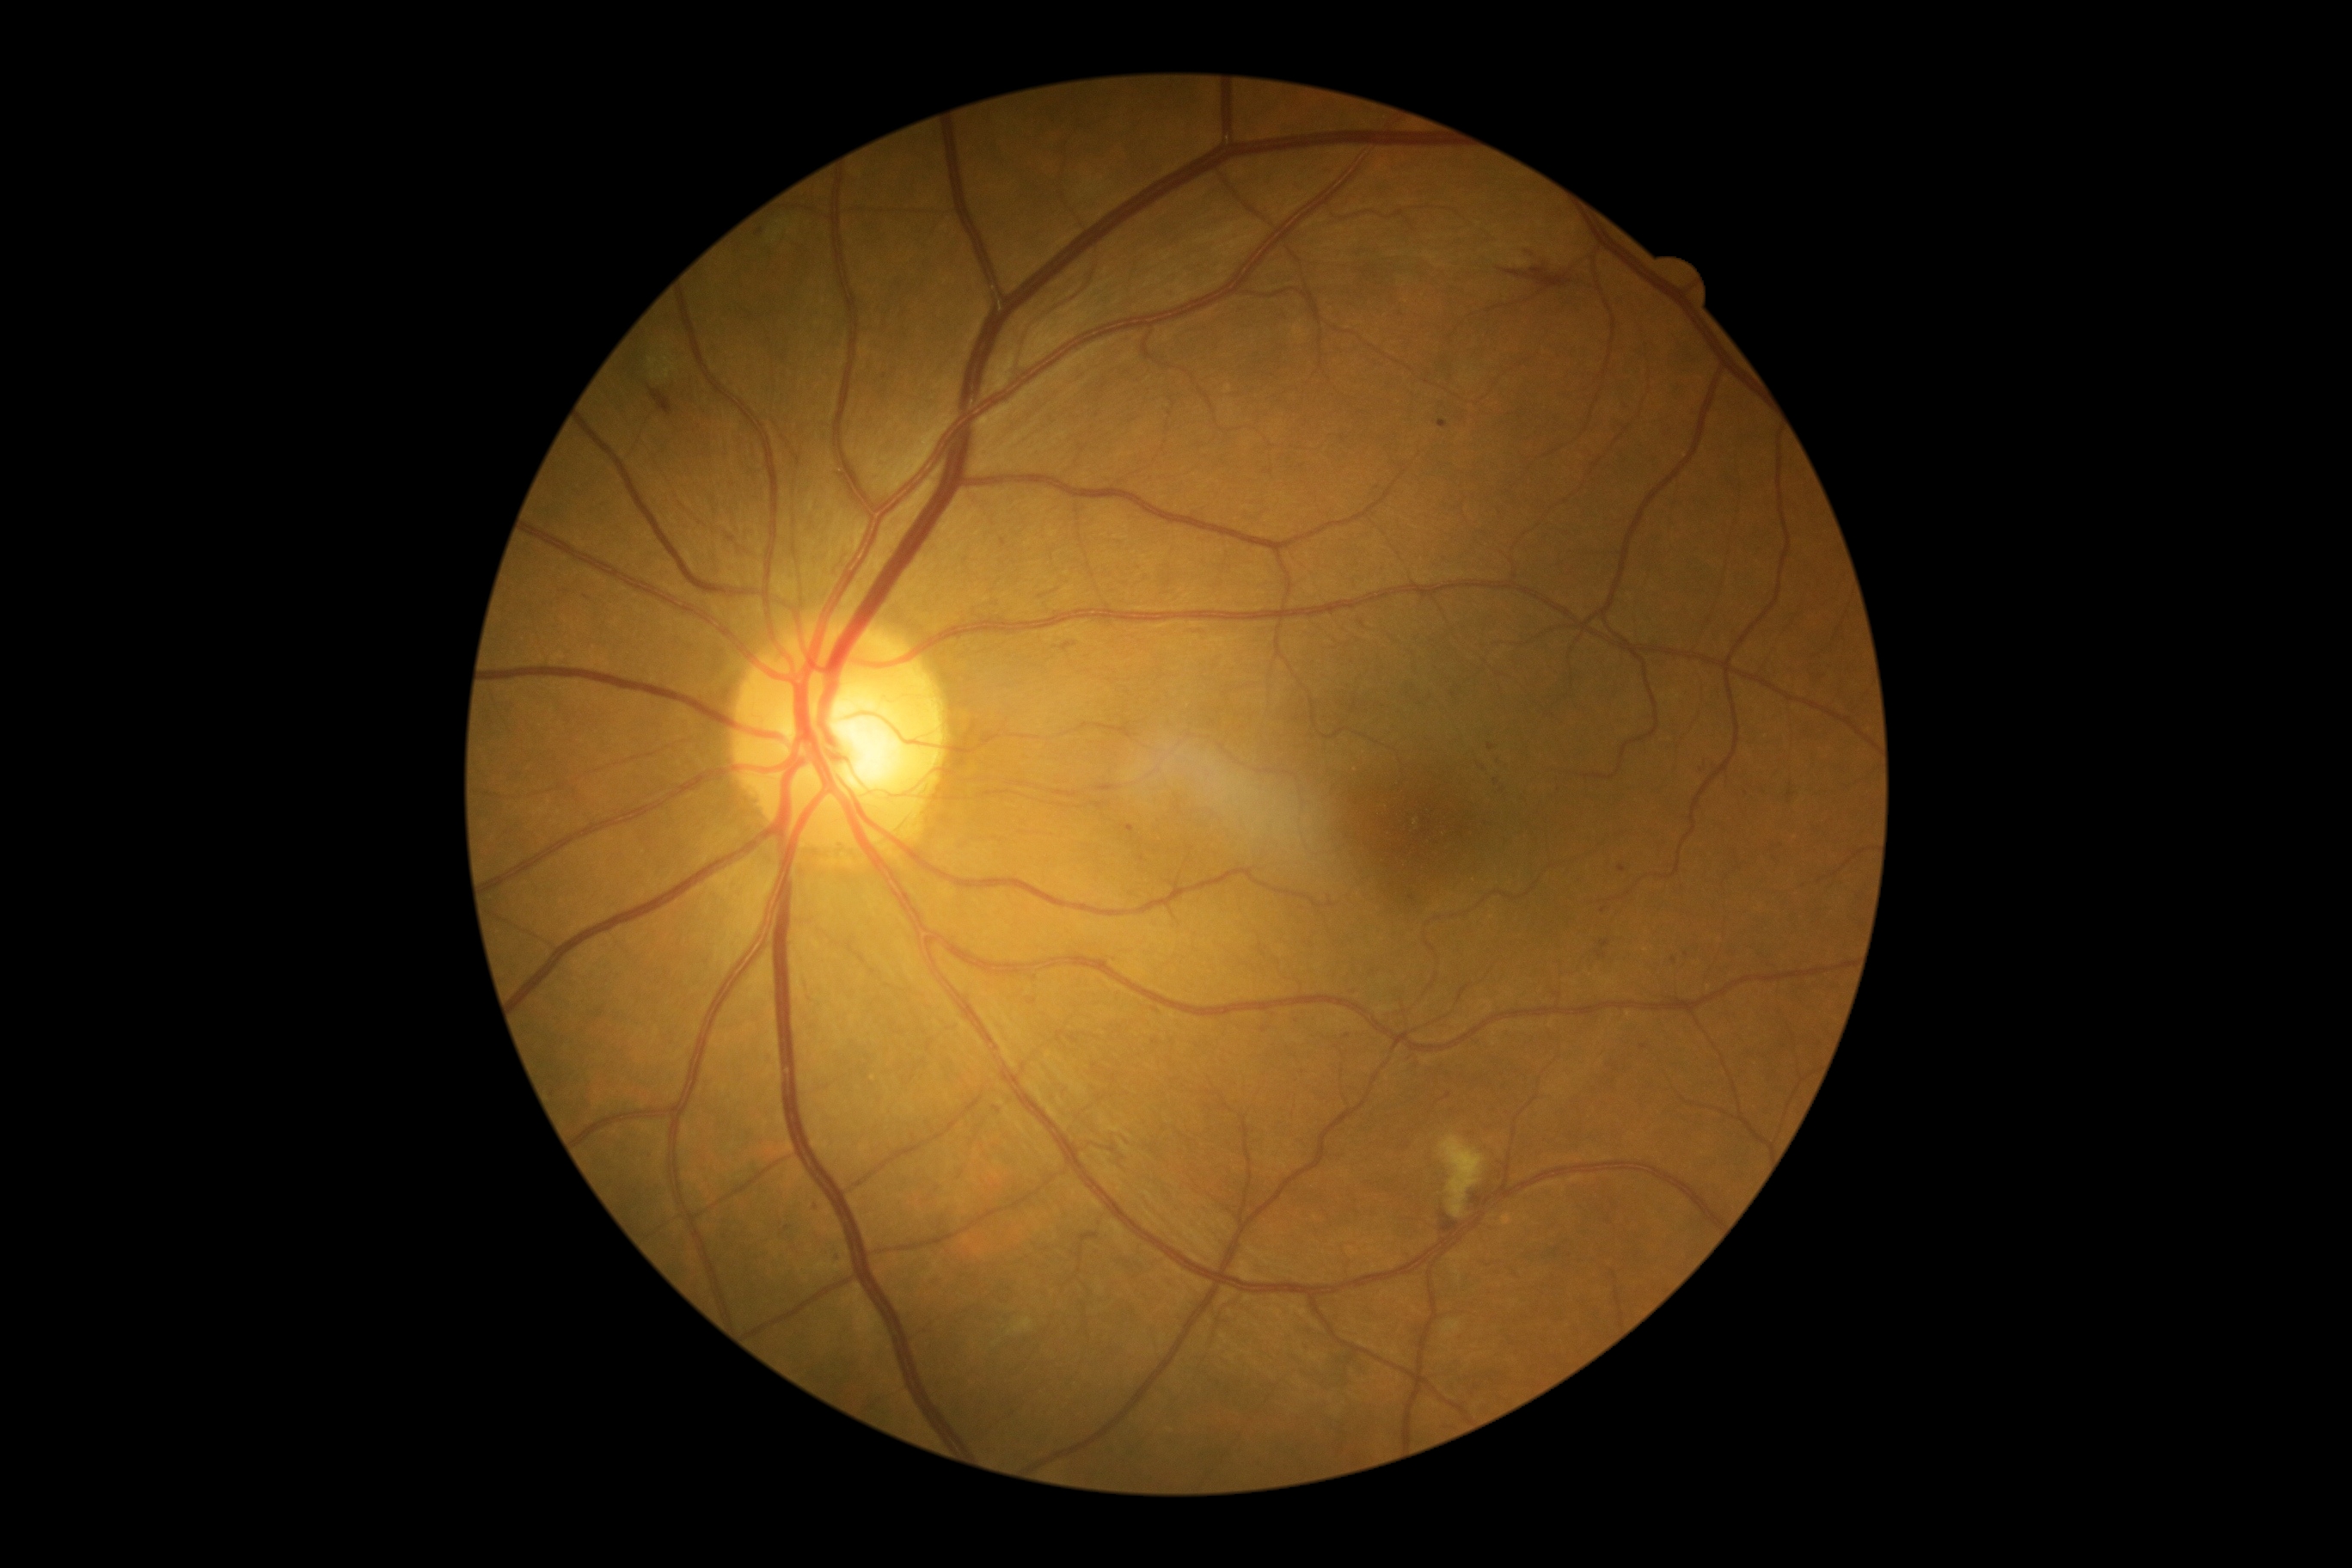
Diabetic retinopathy (DR): grade 2
Representative lesions:
microaneurysms (MAs) (more not shown): x1=1596, y1=952, x2=1607, y2=960; x1=1063, y1=644, x2=1072, y2=651; x1=1069, y1=1034, x2=1079, y2=1043; x1=1619, y1=866, x2=1626, y2=874
Additional small MAs near {"x": 1703, "y": 770}; {"x": 1604, "y": 911}; {"x": 1412, "y": 898}; {"x": 1004, "y": 542}; {"x": 1348, "y": 1036}; {"x": 1491, "y": 747}; {"x": 816, "y": 1207}; {"x": 1643, "y": 1048}; {"x": 1559, "y": 994}